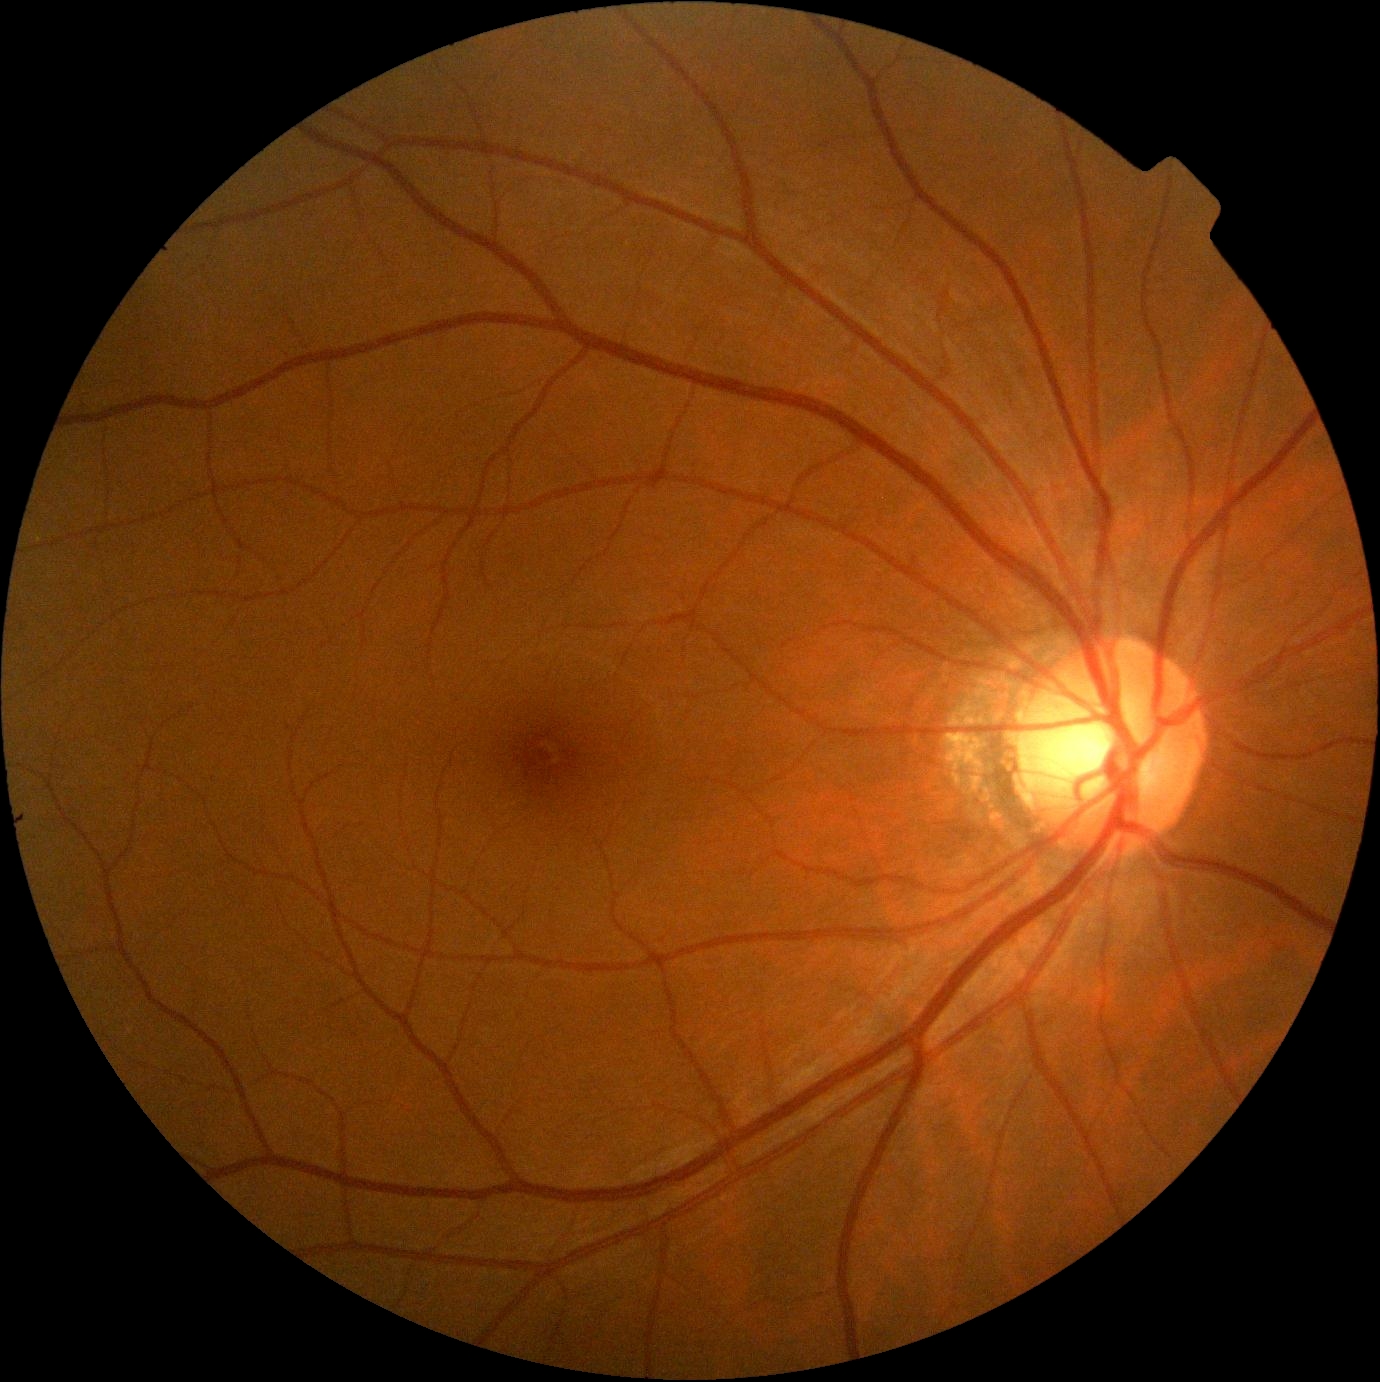 Diabetic retinopathy (DR) is grade 0.